45 degree fundus photograph: 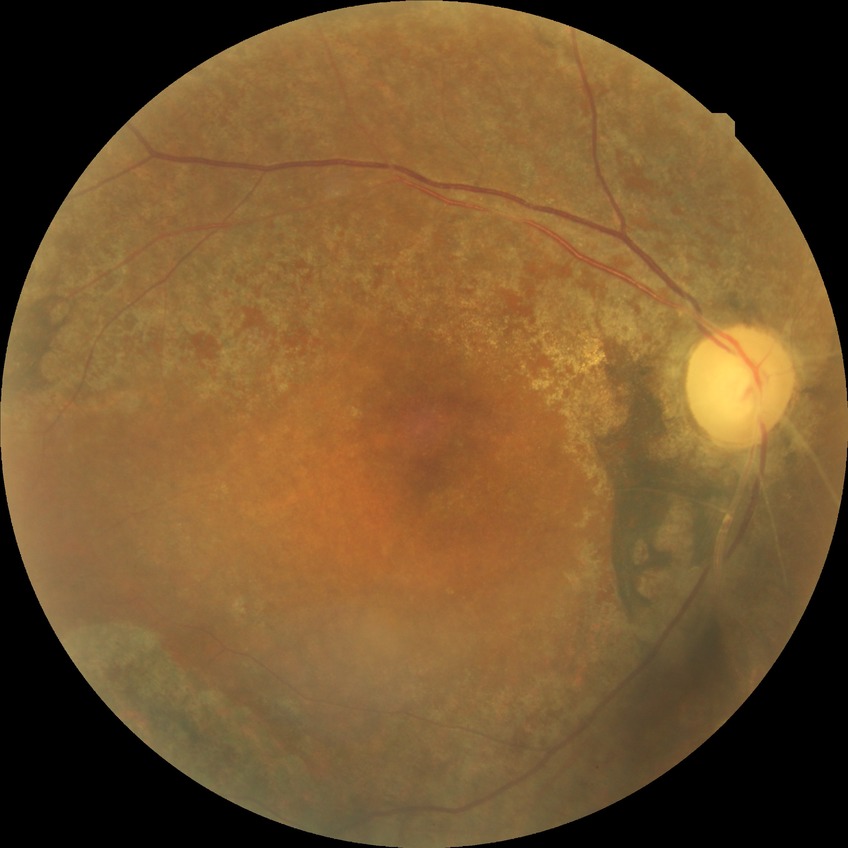

Annotations:
- diabetic retinopathy (DR) — no diabetic retinopathy (NDR)